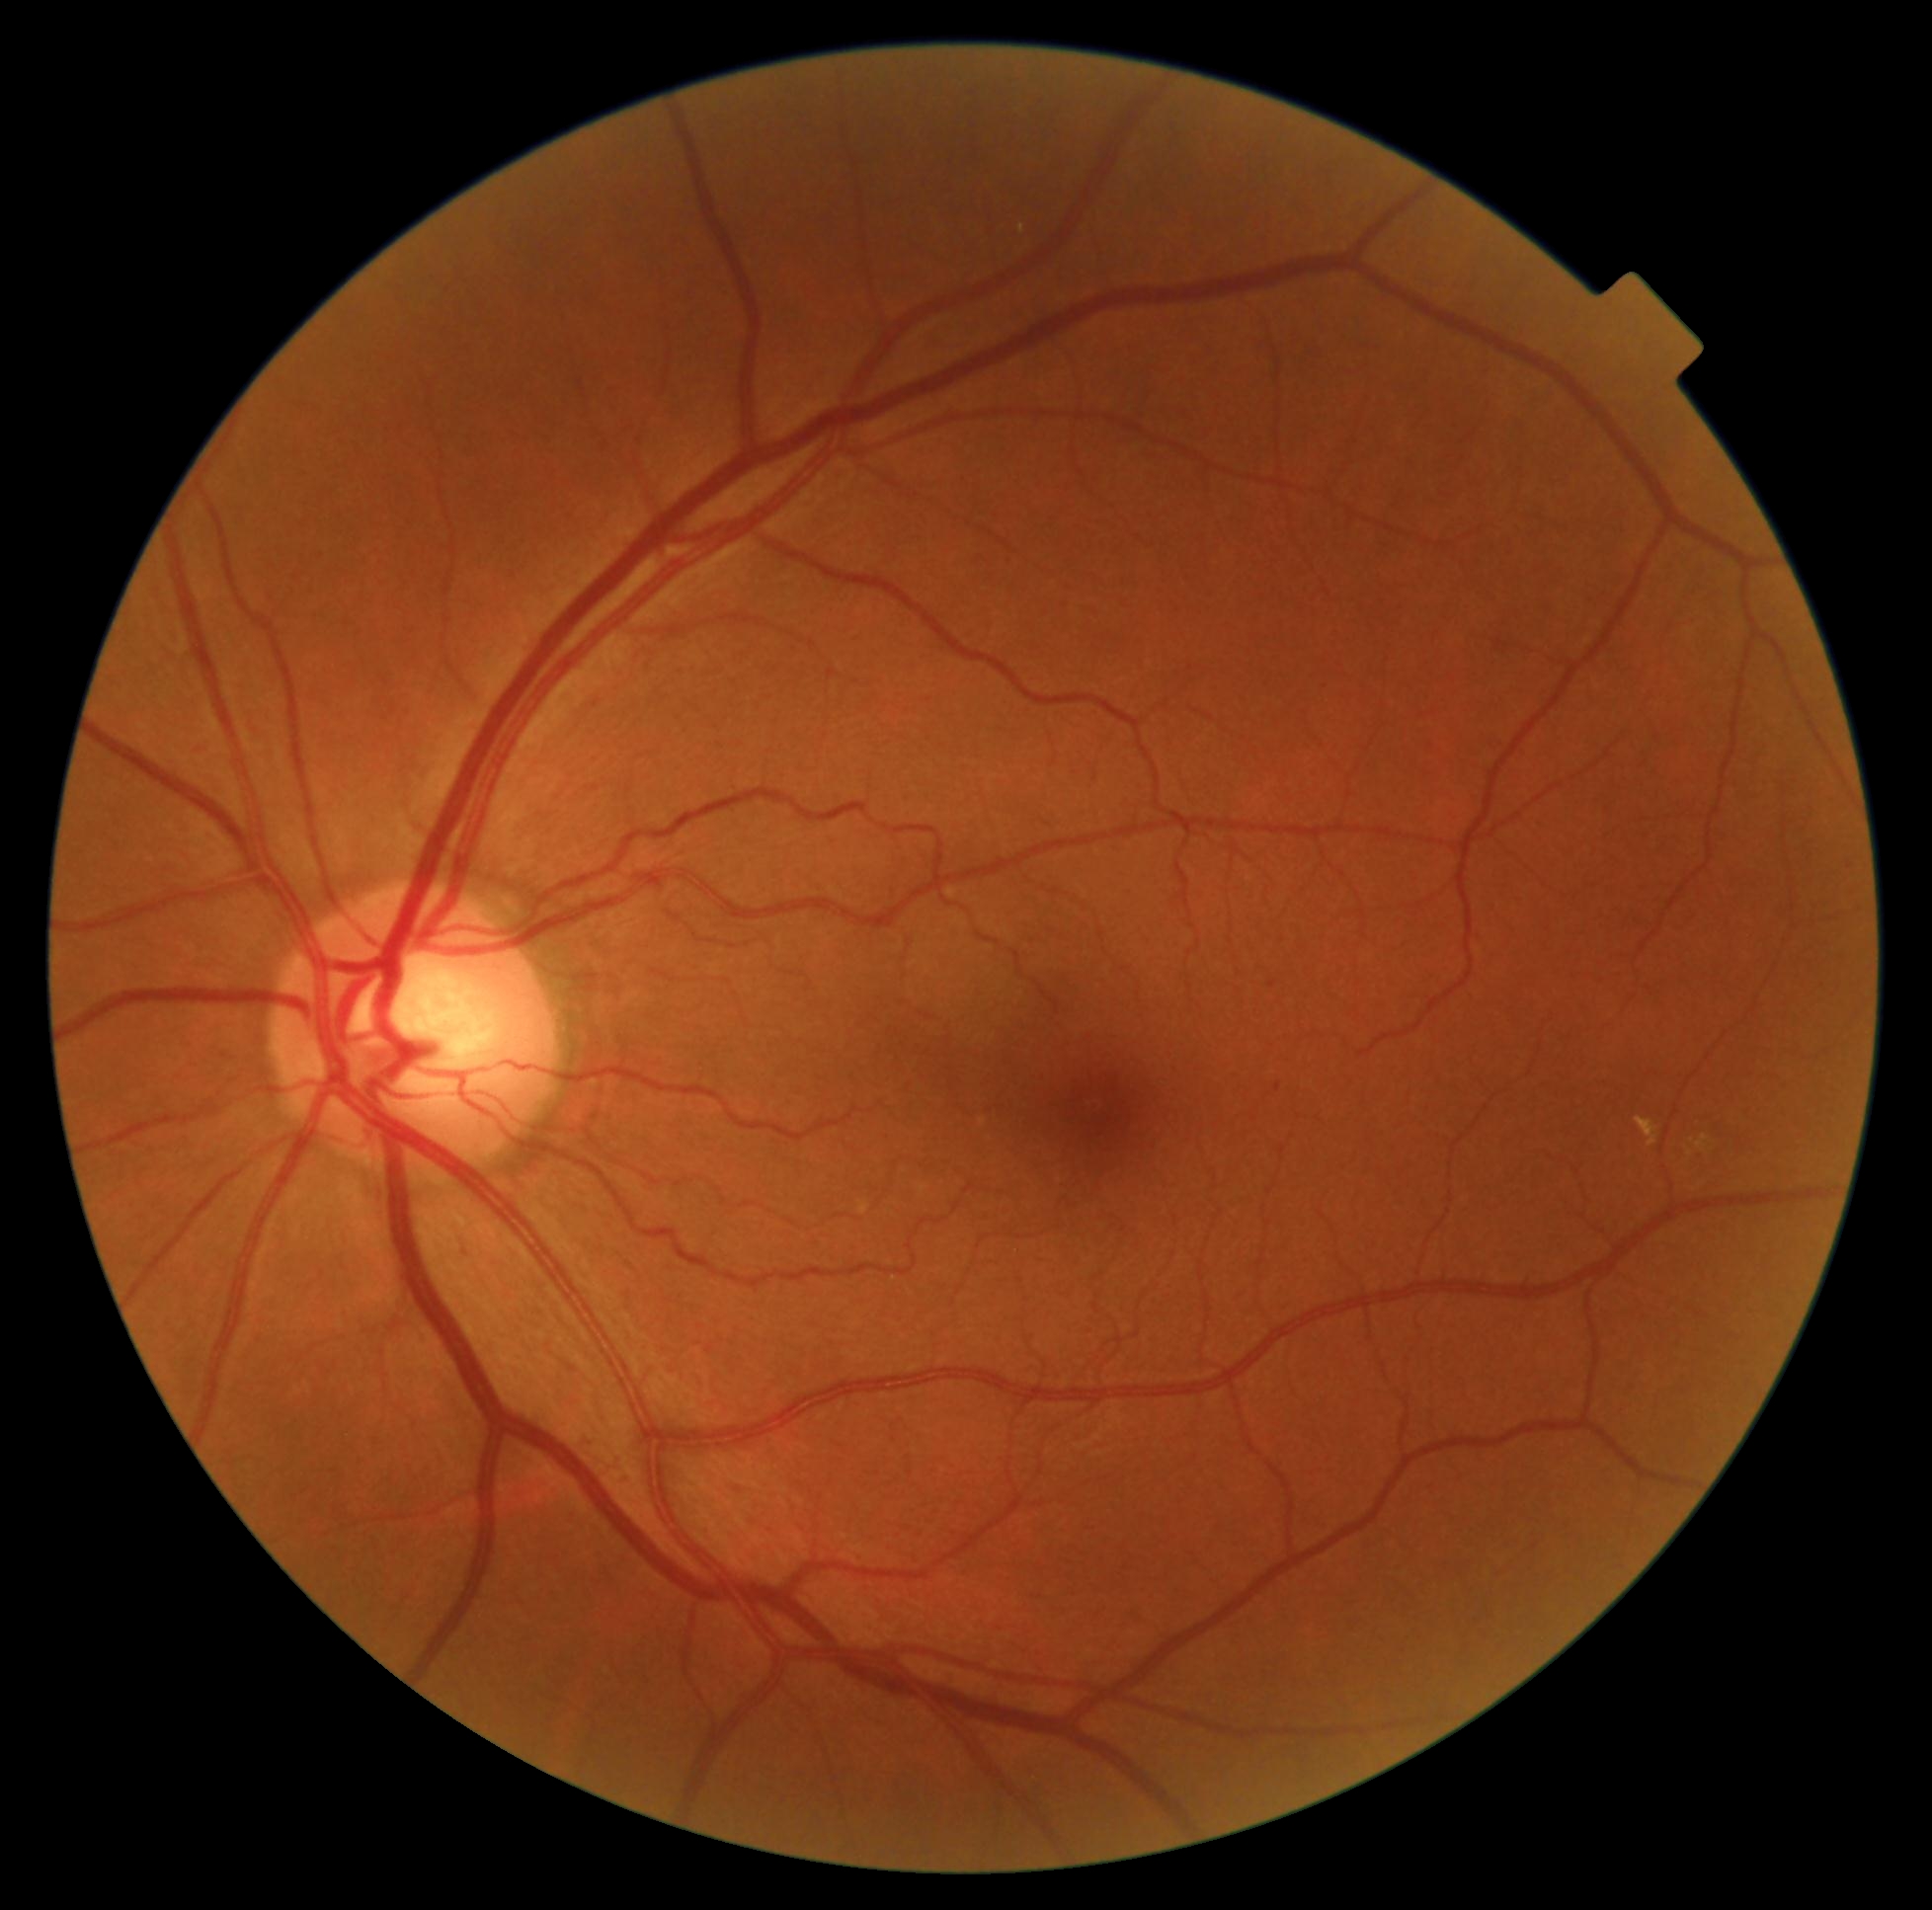
DR severity: 2/4.